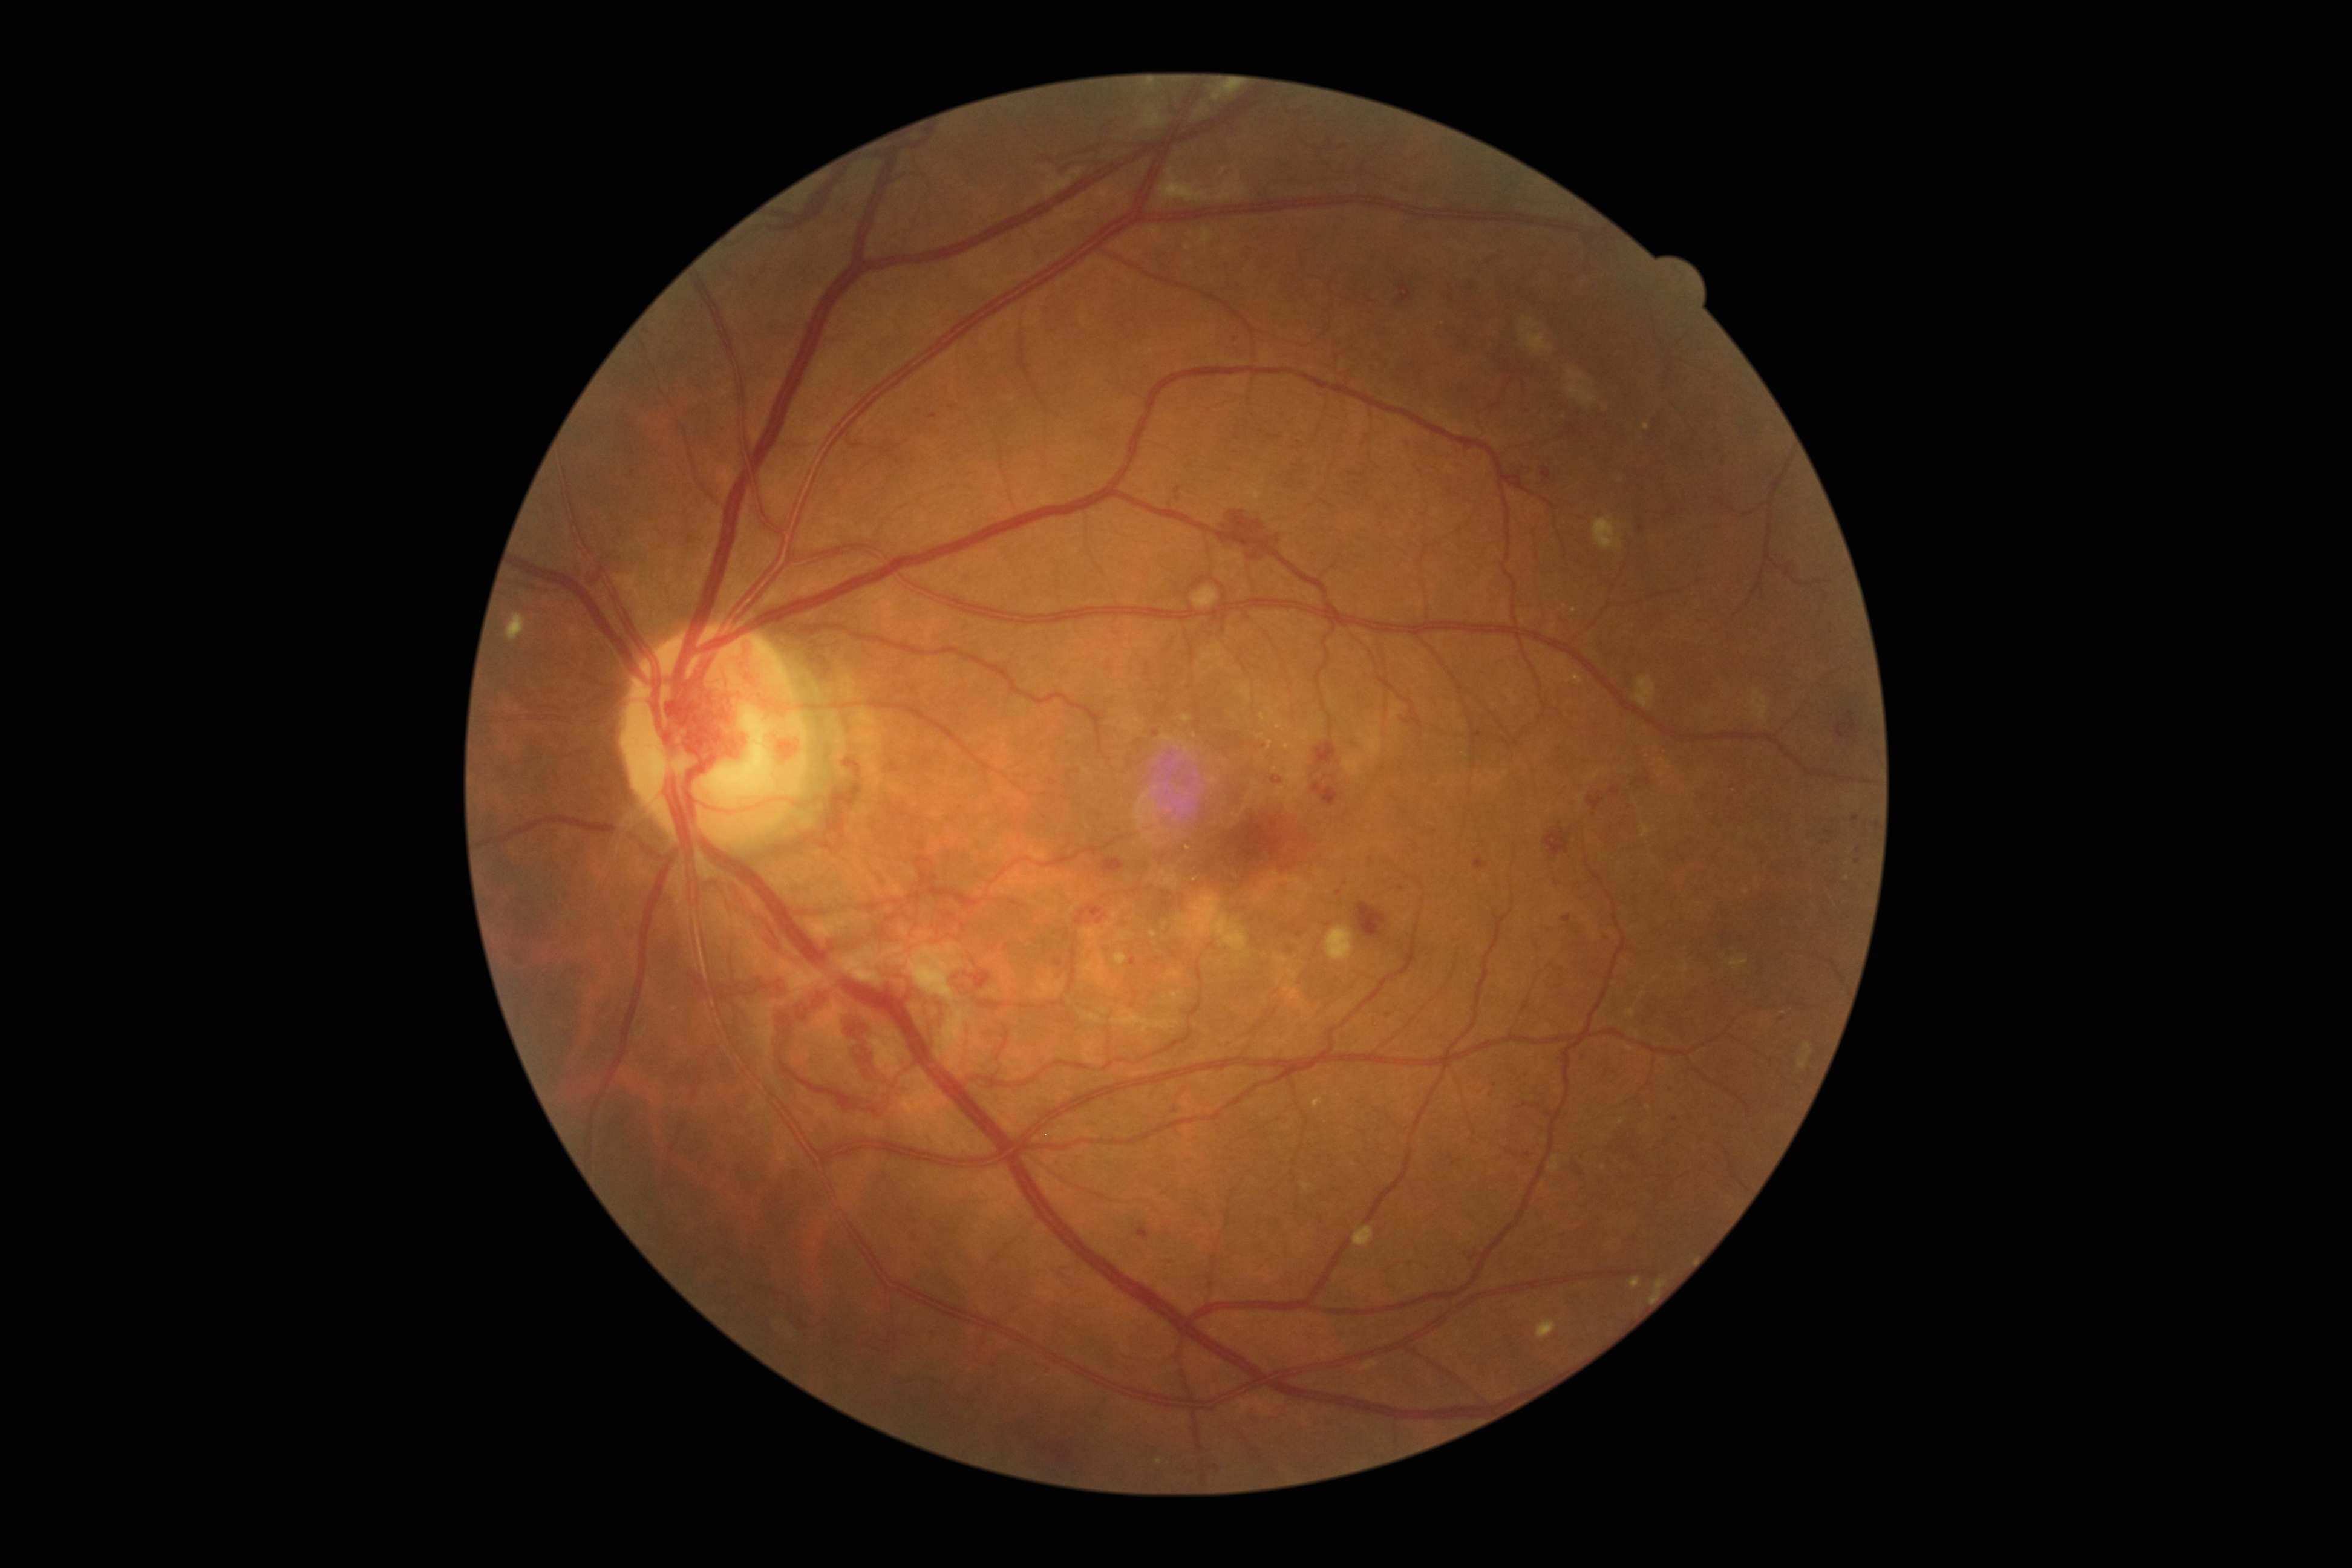
retinopathy grade: PDR (4)